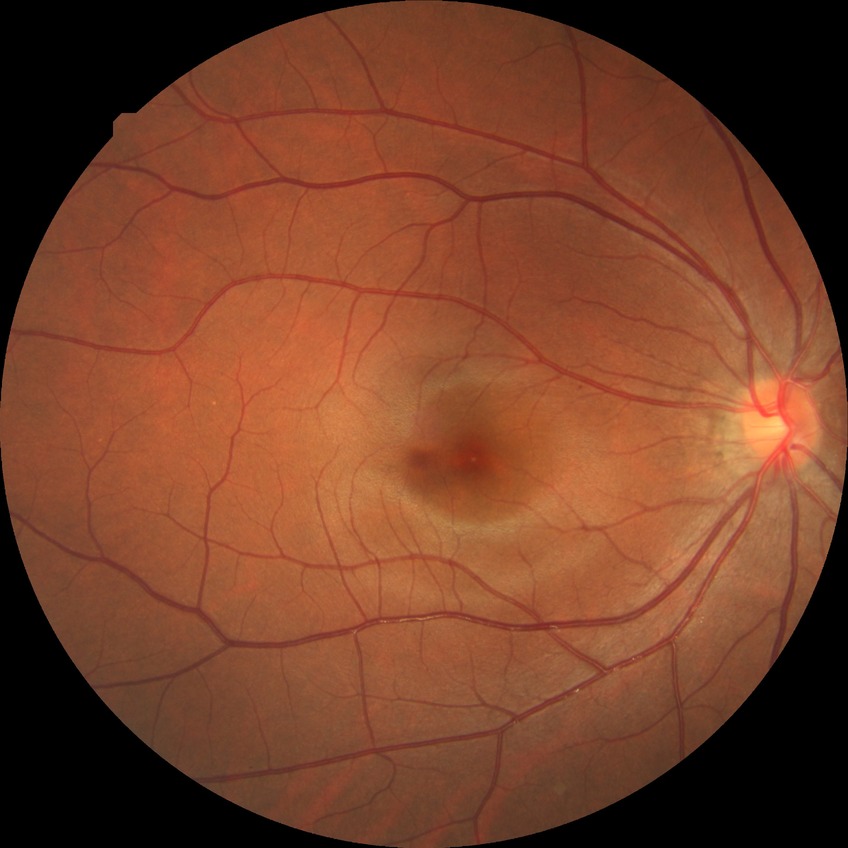 Retinopathy grade: no diabetic retinopathy.